Image size 1923x1932. CFP — 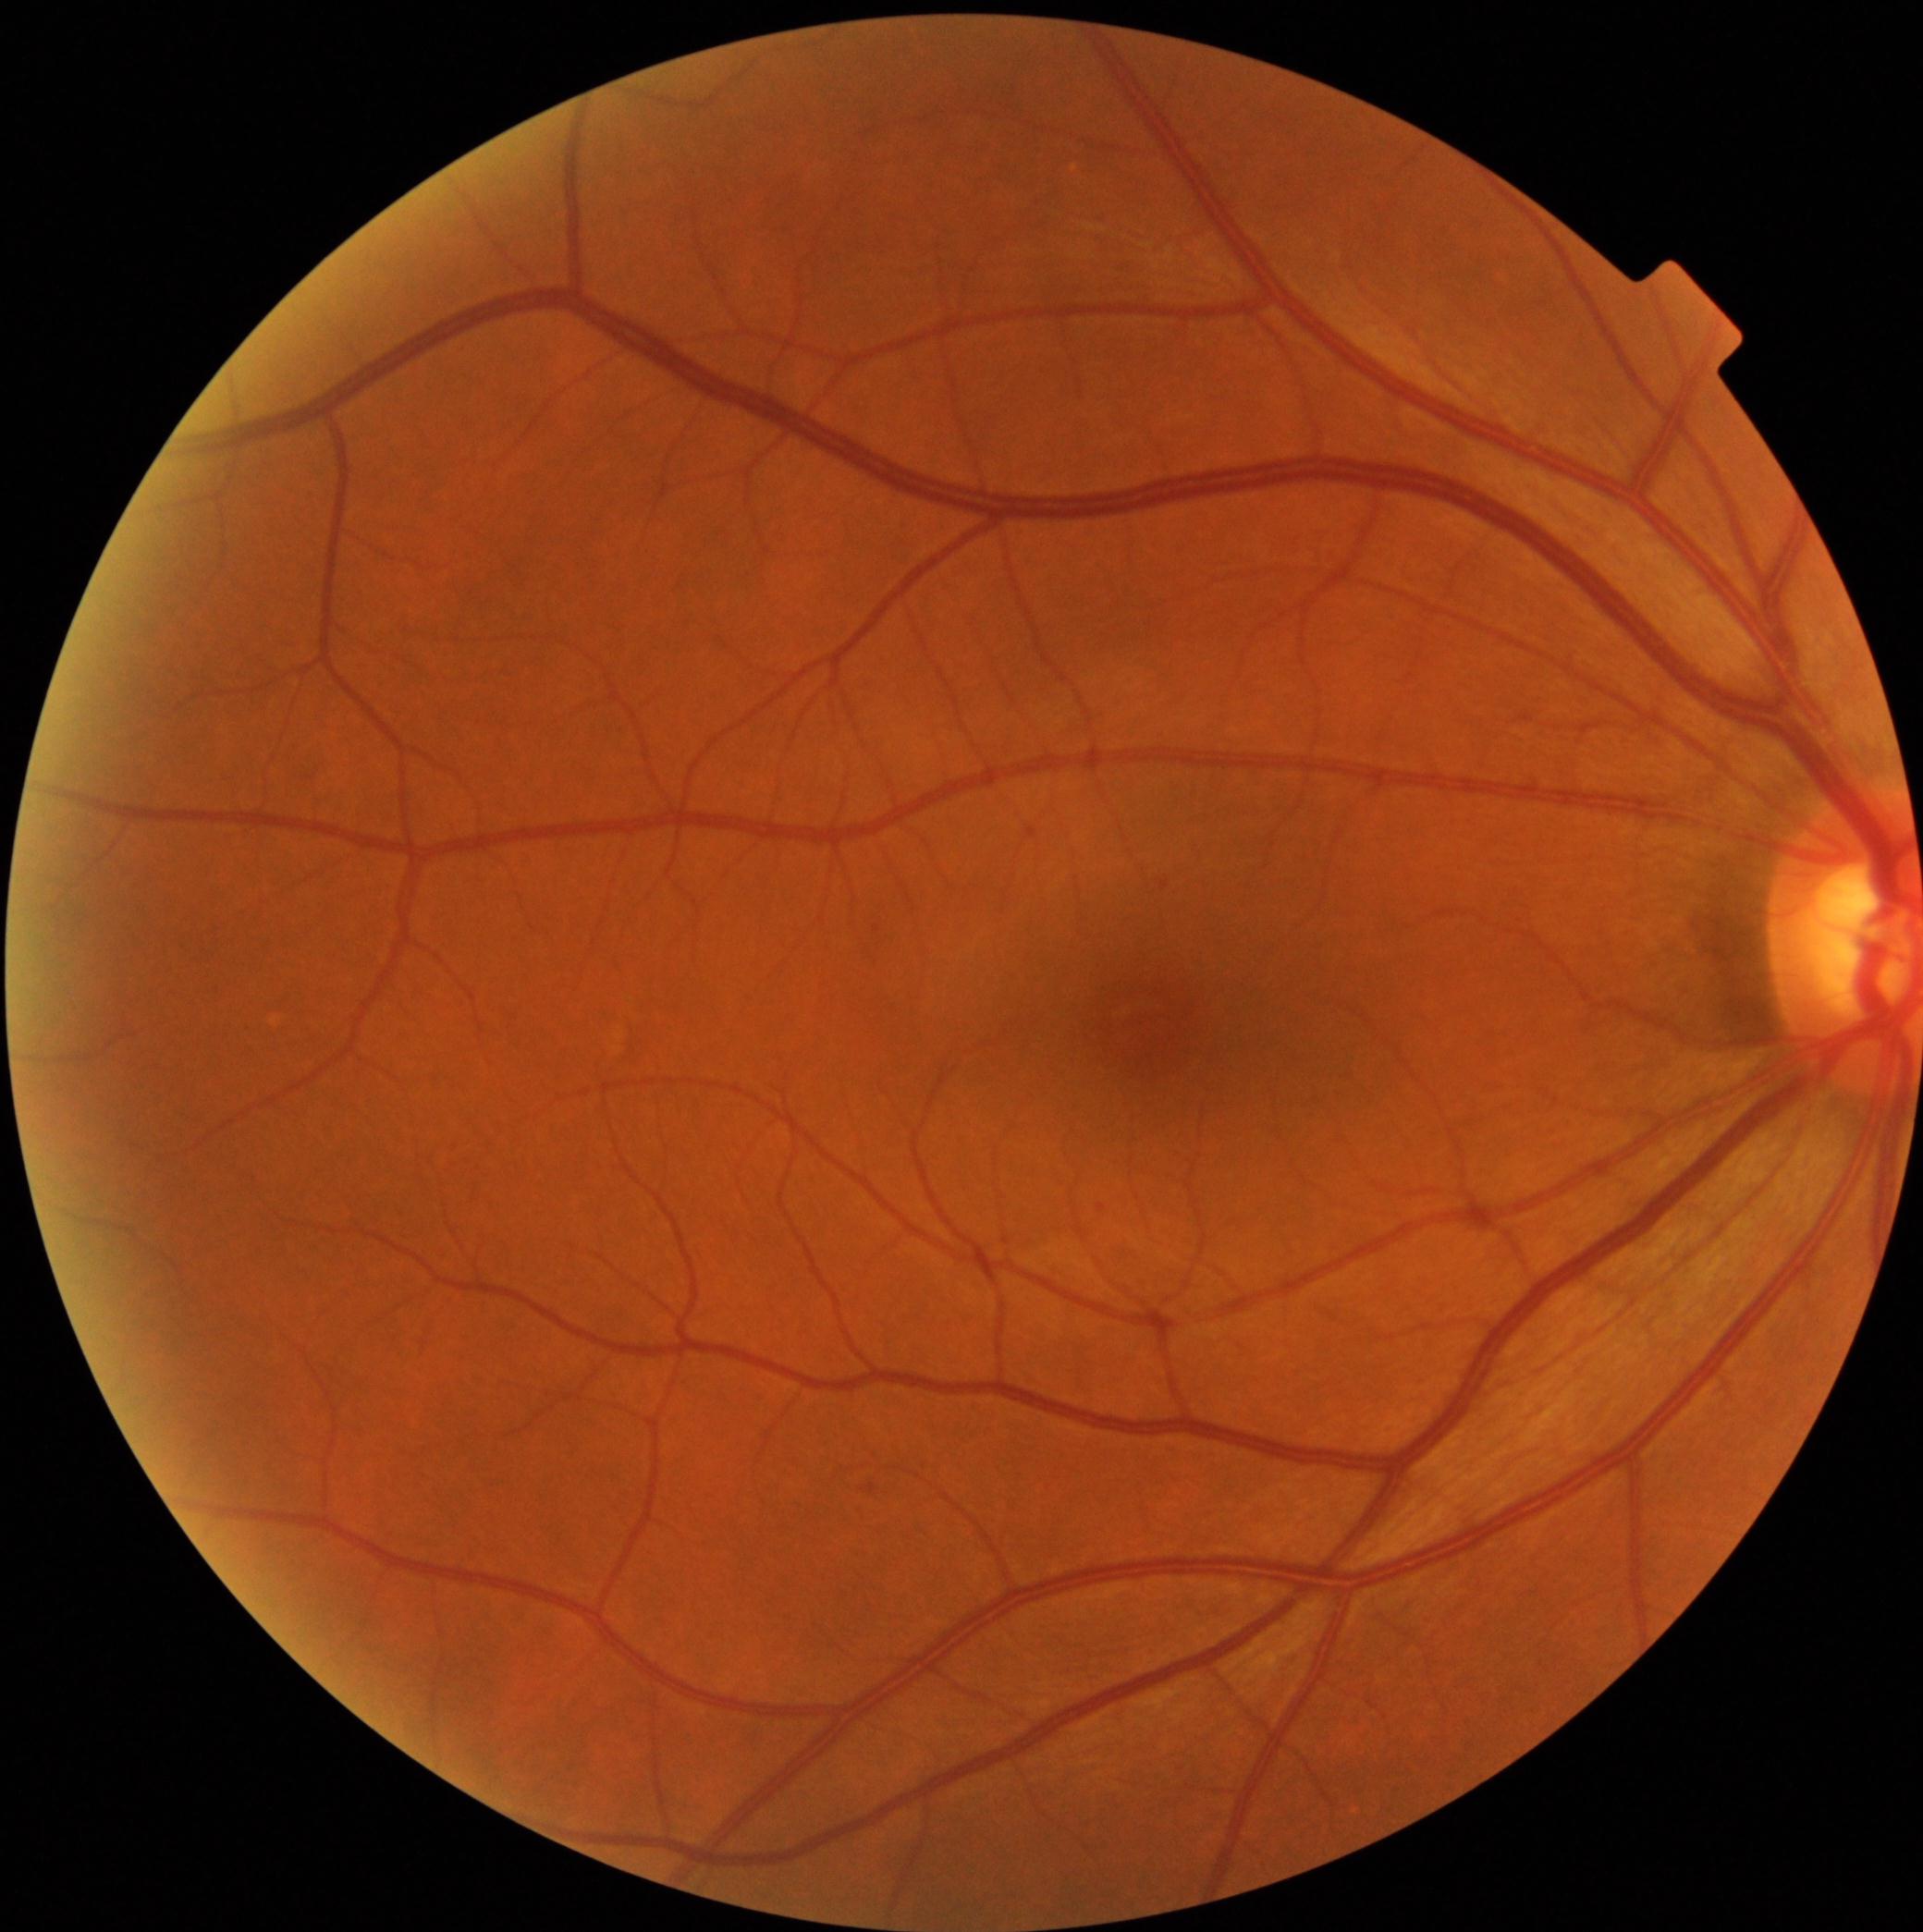
Diabetic retinopathy (DR) is mild non-proliferative diabetic retinopathy (grade 1). Disease class: non-proliferative diabetic retinopathy.